Image size 848x848: 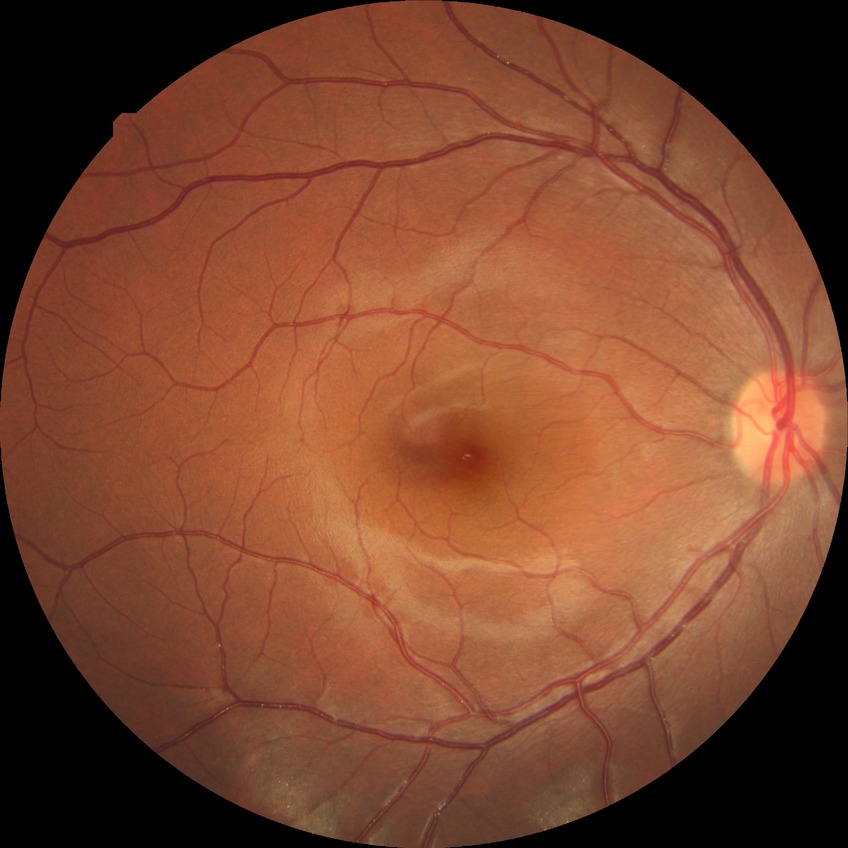 No signs of diabetic retinopathy. DR stage: NDR.